130° field of view (Clarity RetCam 3); infant wide-field fundus photograph:
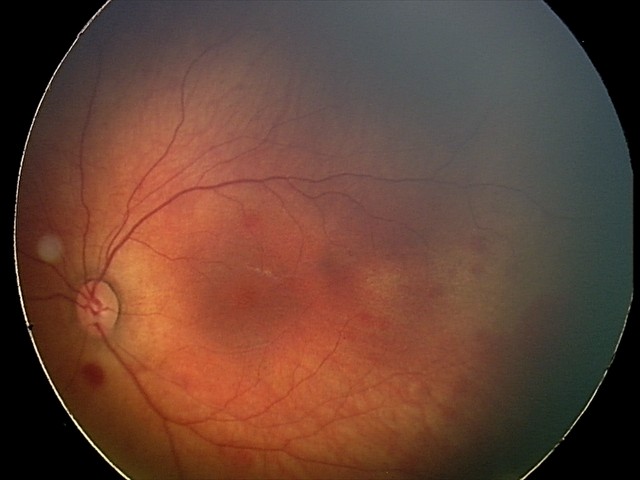
Diagnosis from this screening exam: retinal hemorrhages.